45° FOV — 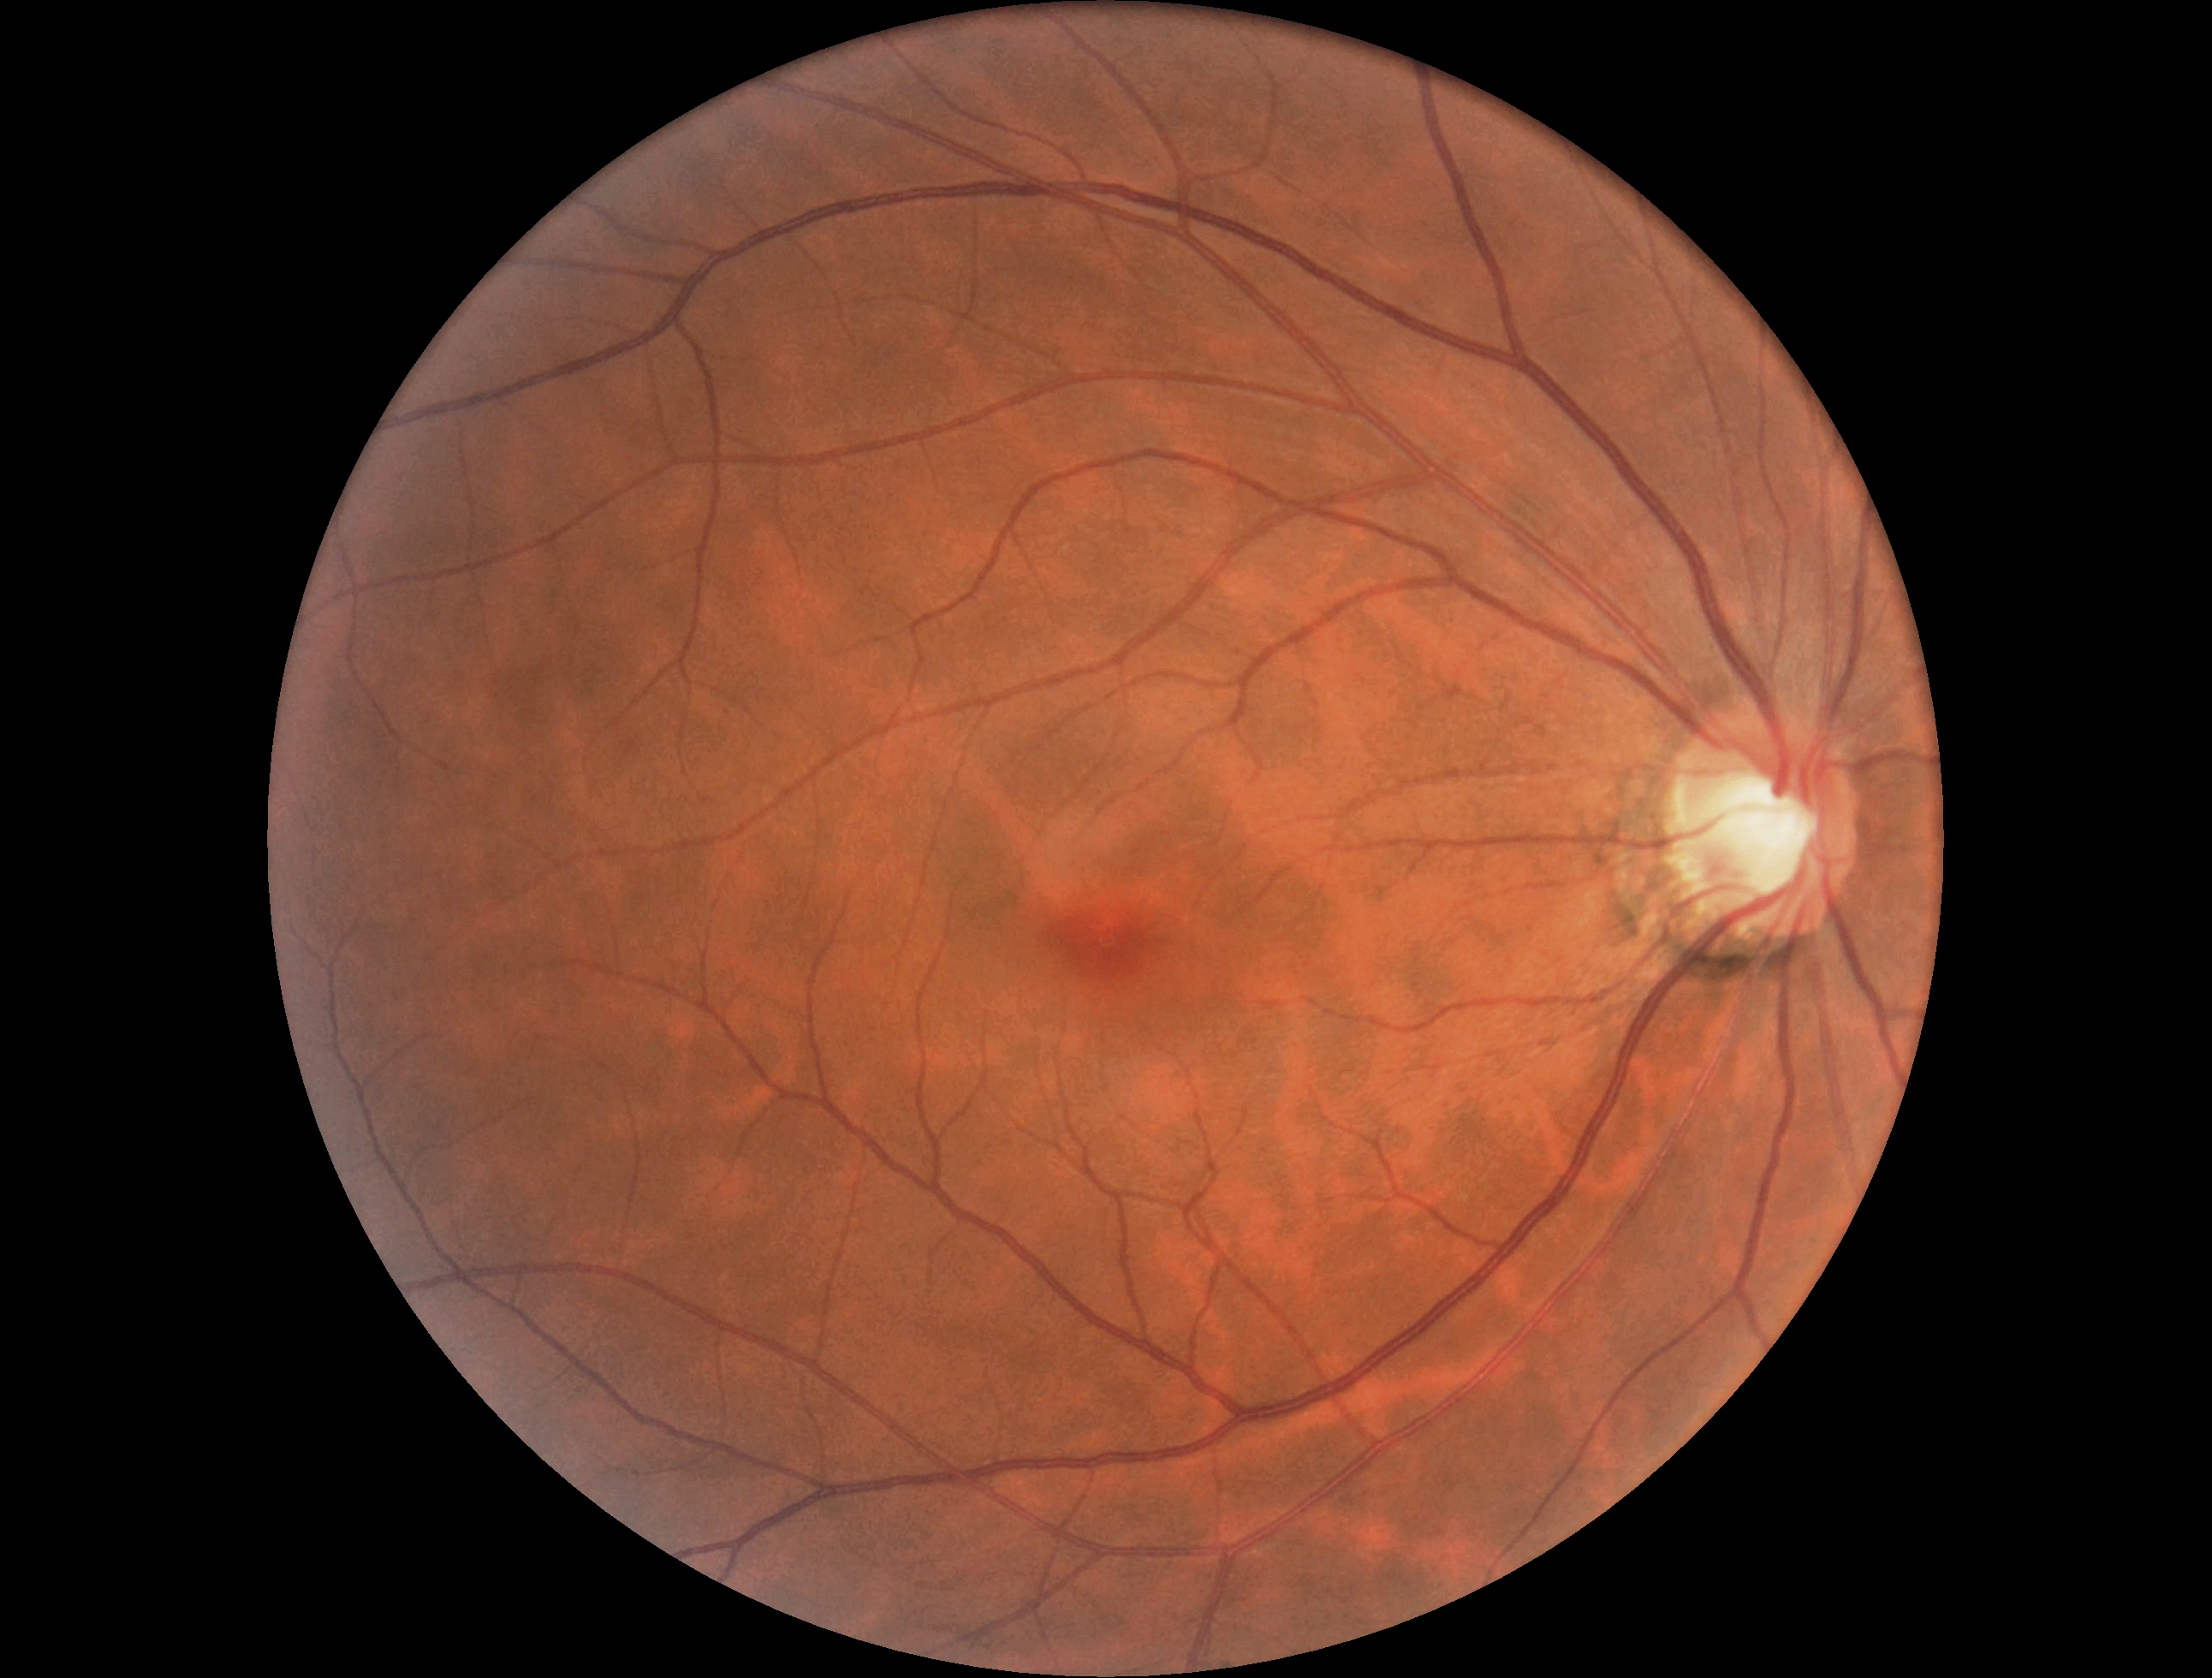 DR grade: 0, DR impression: no DR findings.